Image size 2212x1659 · portable fundus camera image · 60° FOV: 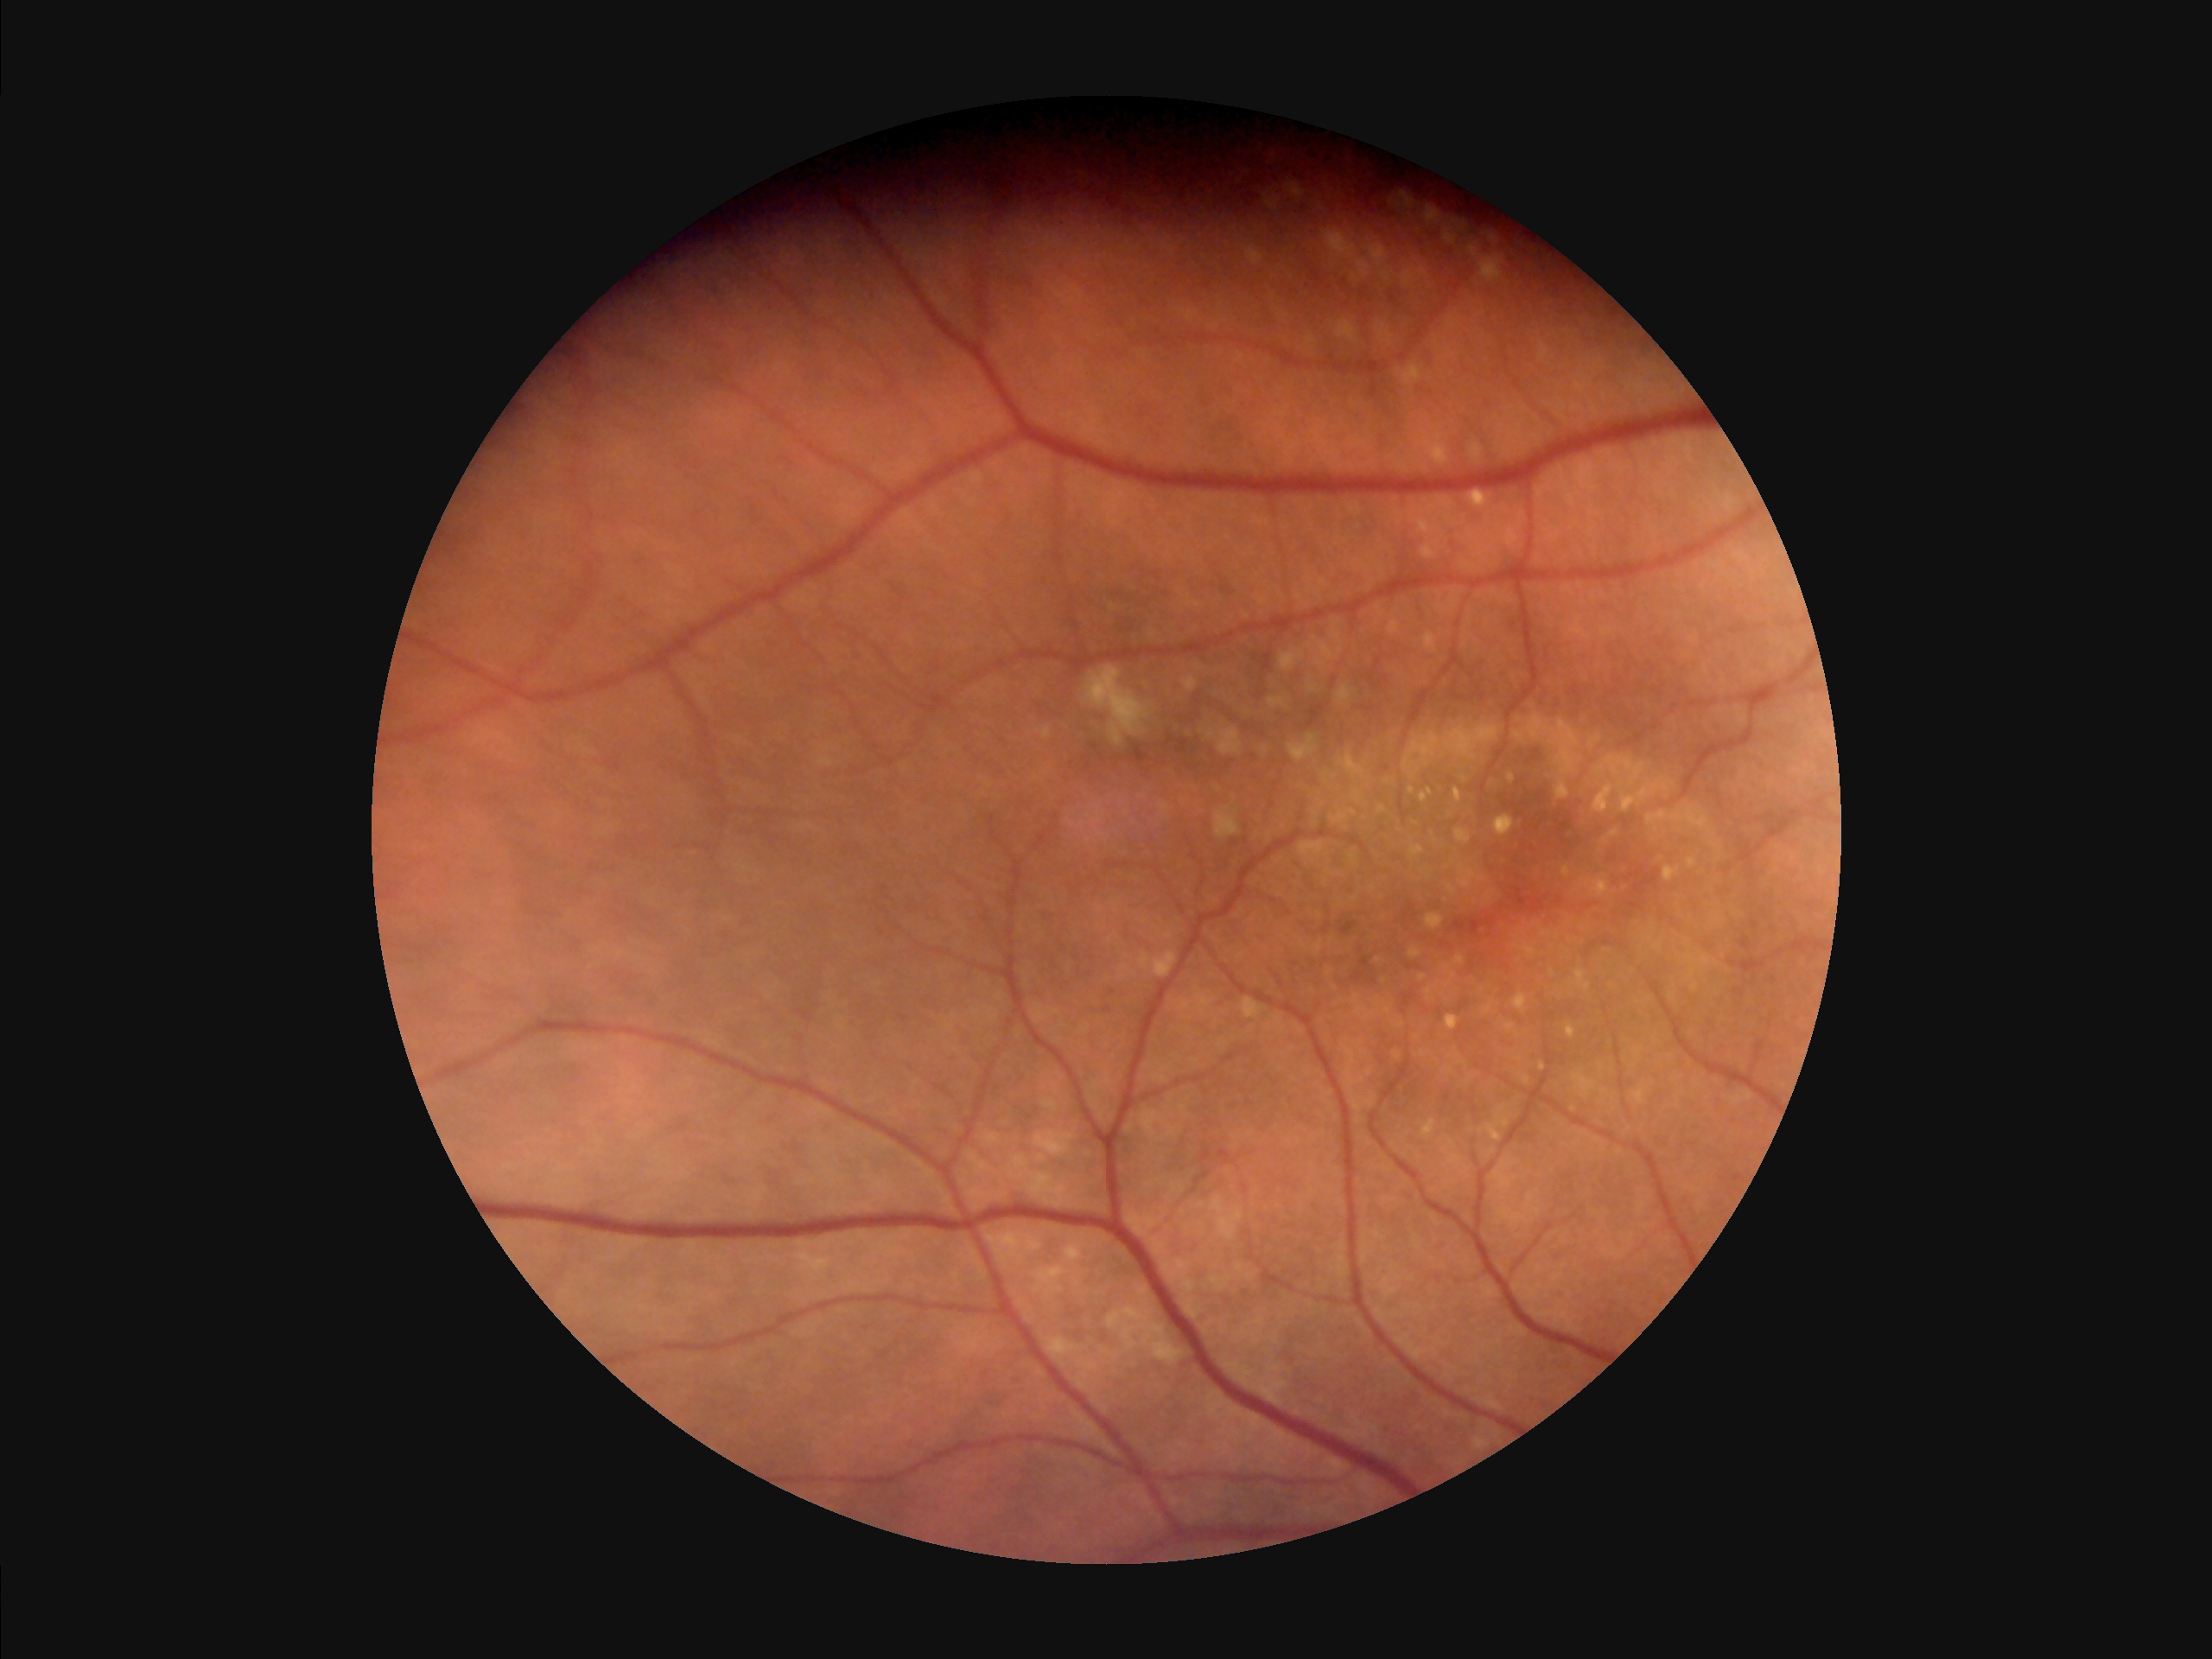
Illumination/color = even and well-balanced
Overall image quality = adequate for clinical interpretation
Focus = sharp throughout the field